Portable fundus photograph. 60-degree field of view. Image size 2212x1659.
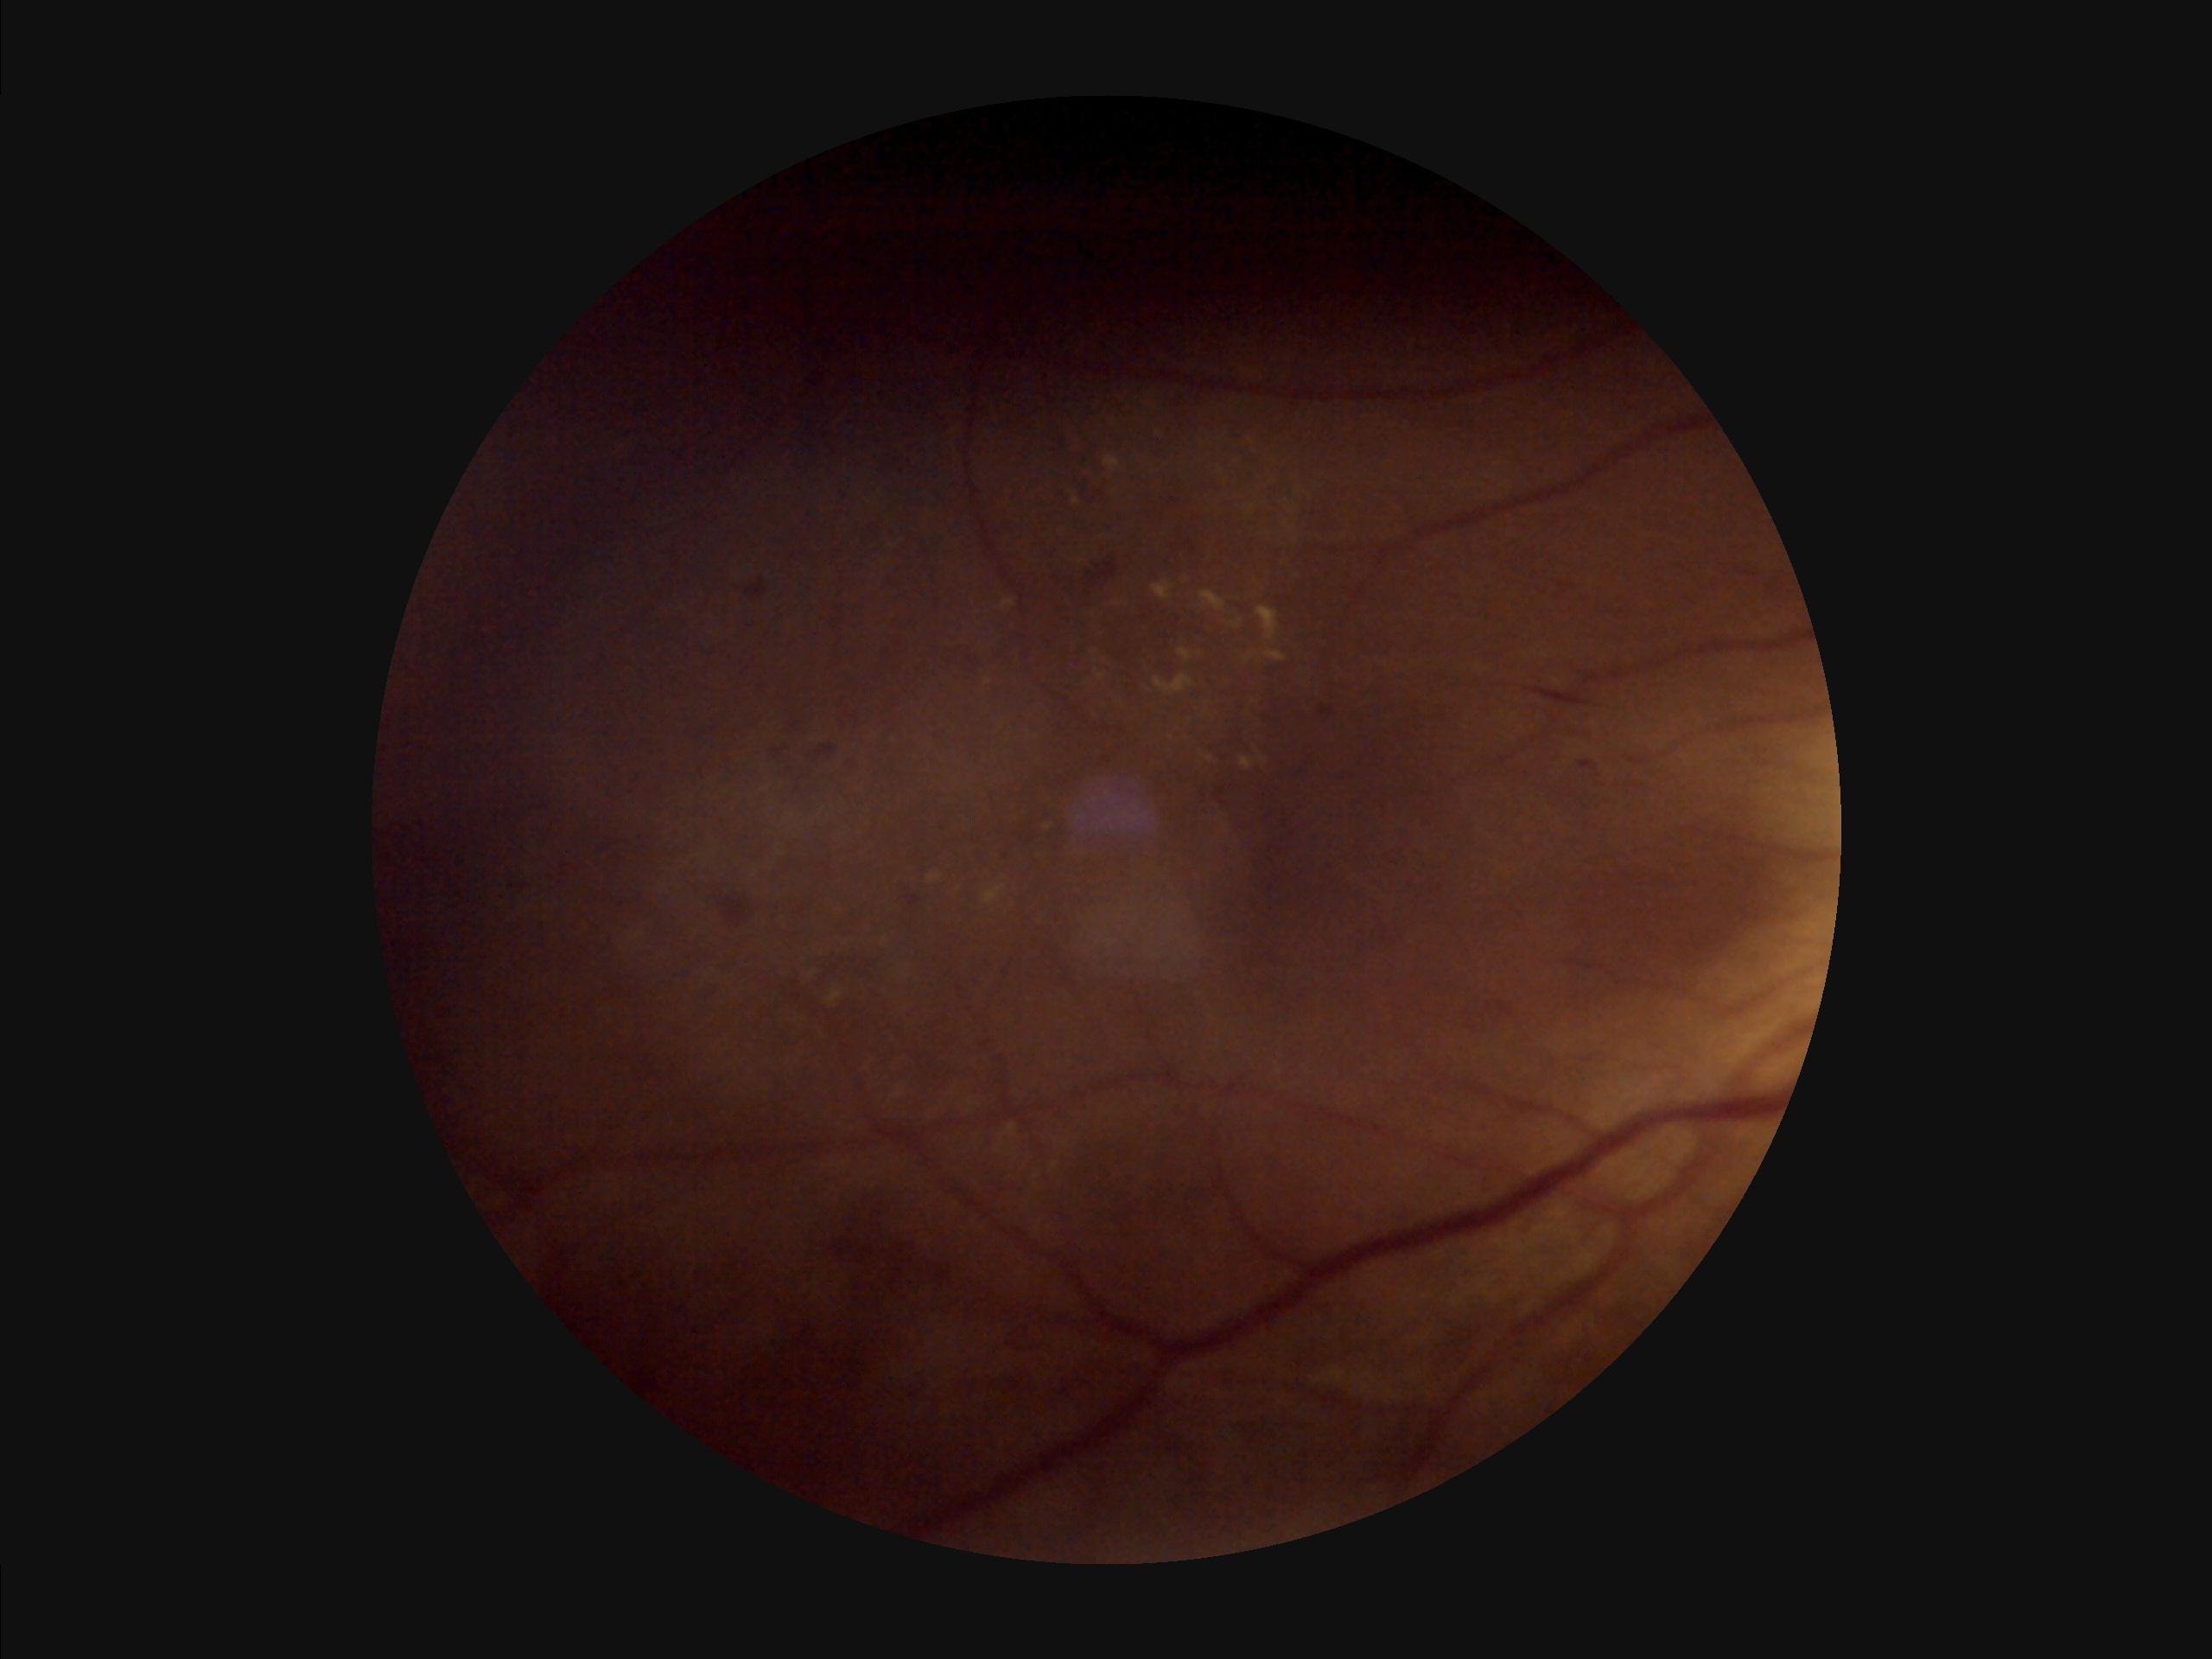 Illumination: over- or under-exposed; Contrast: narrow intensity range, structures hard to distinguish; Focus: noticeable blur in the optic disc, vessels, or background; Overall image quality: poor, ungradable.